Color fundus image — 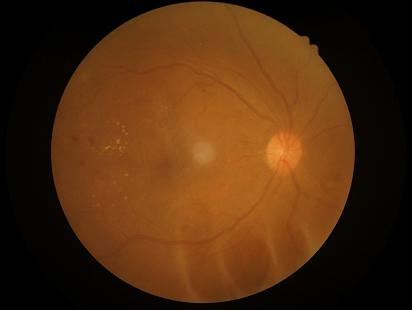 Focus: clear
Overall image quality: suboptimal
Illumination: suboptimal
Contrast: poor